45° field of view · image size 2352x1568 · color fundus photograph: 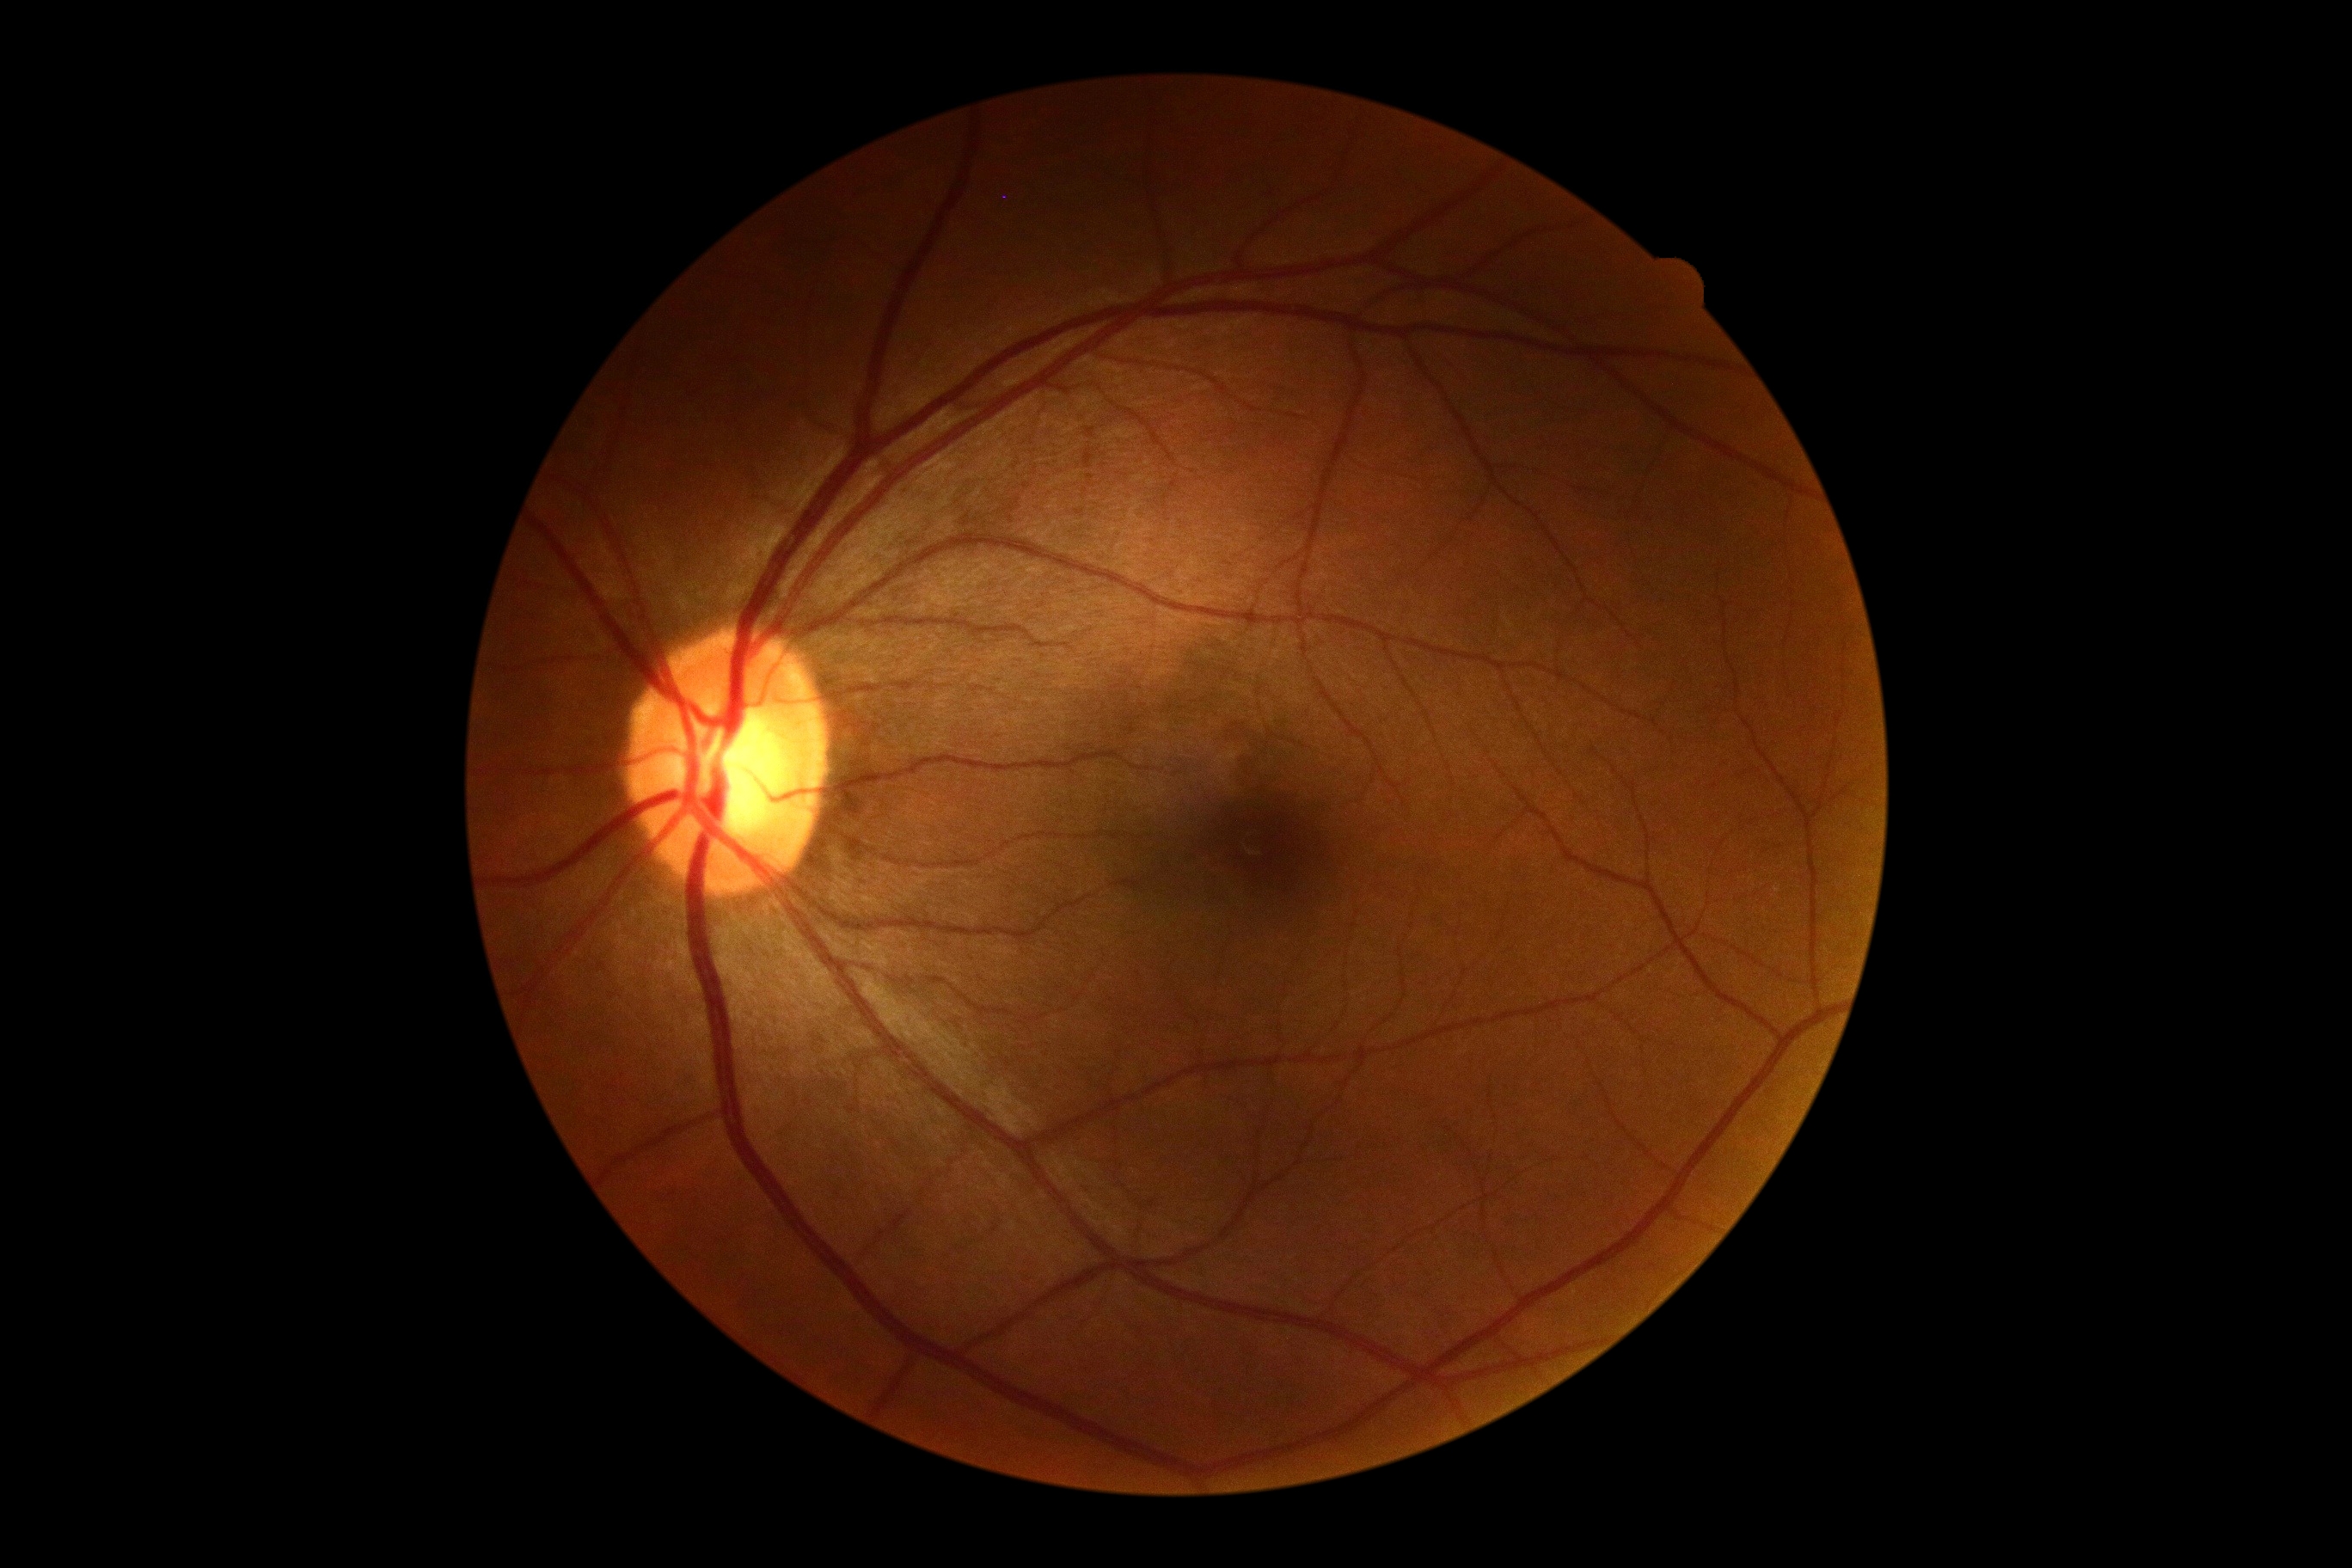
DR severity is 0/4.